45° field of view; retinal fundus photograph; modified Davis classification: 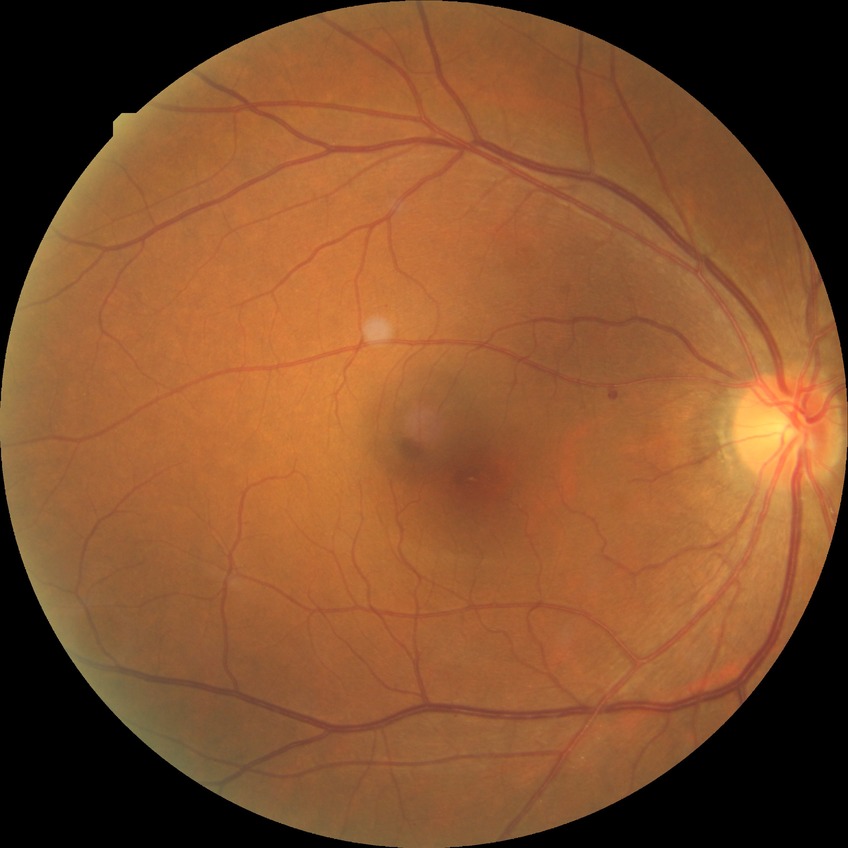

Retinopathy stage: simple diabetic retinopathy.
DR class: non-proliferative diabetic retinopathy.